2228 by 1652 pixels; 50° field of view.
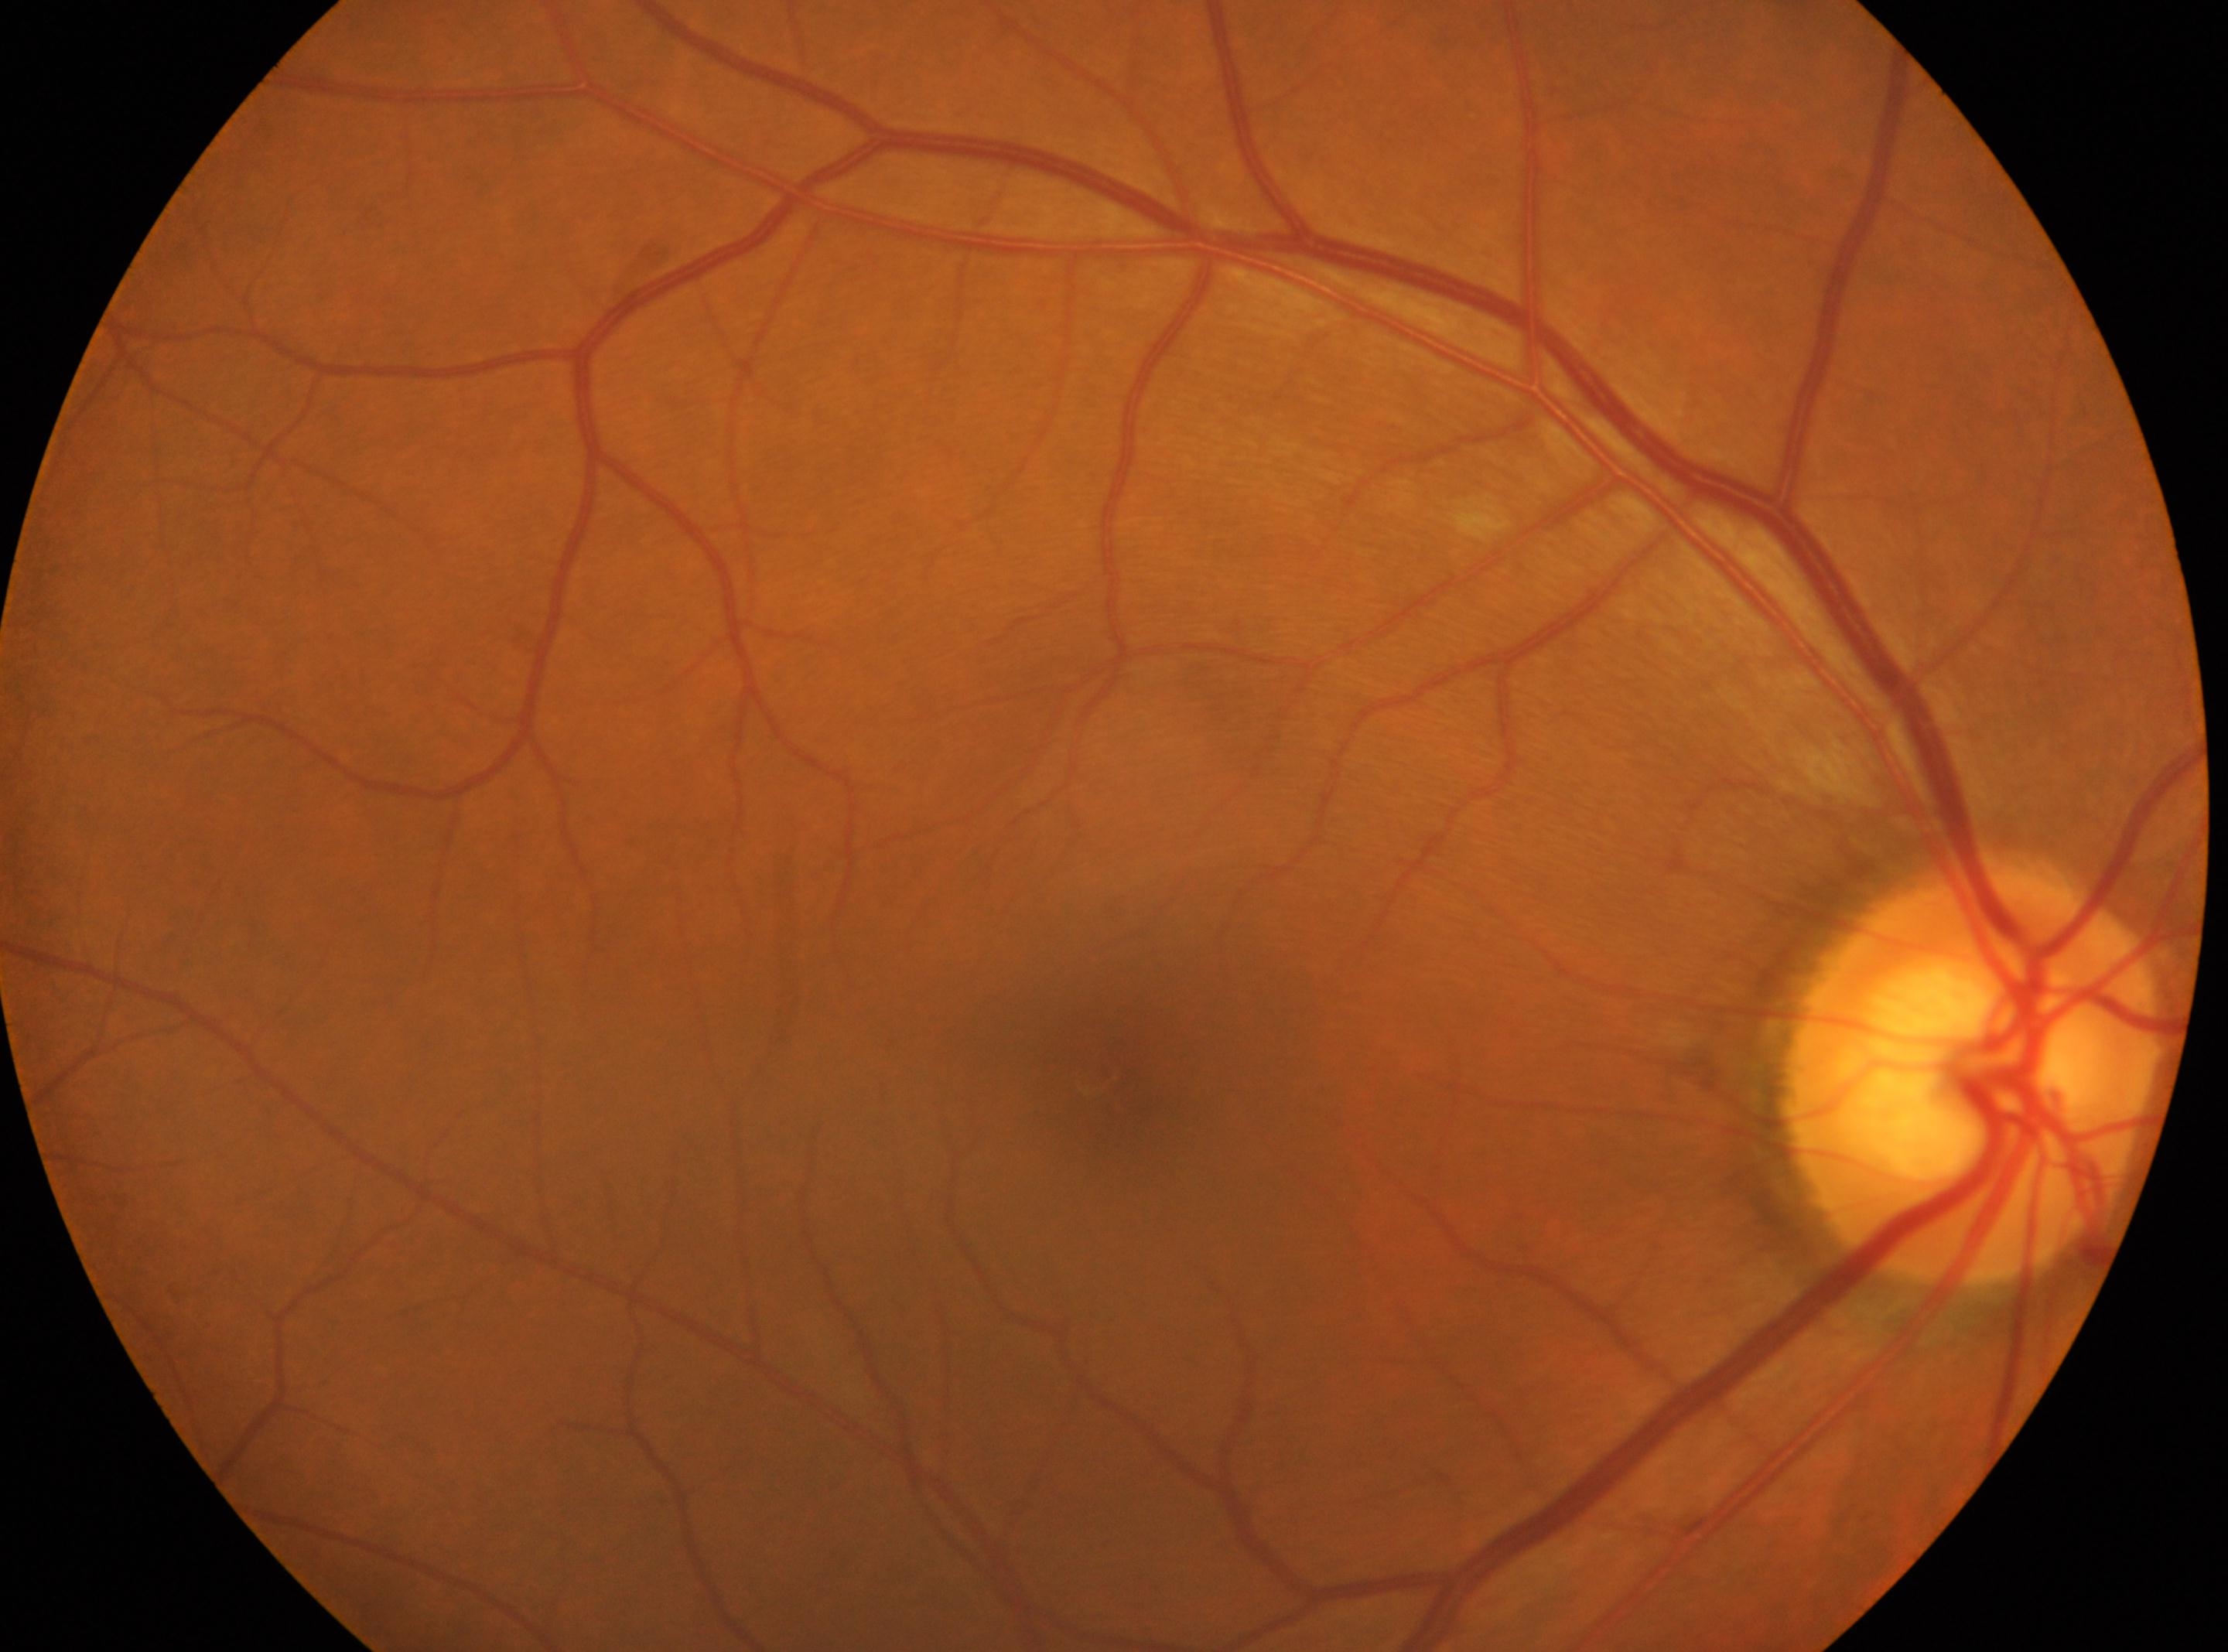

laterality: right, optic nerve head: (1973, 1075), fovea center: (1116, 1075), diabetic retinopathy (DR): 0/4.